FOV: 45 degrees:
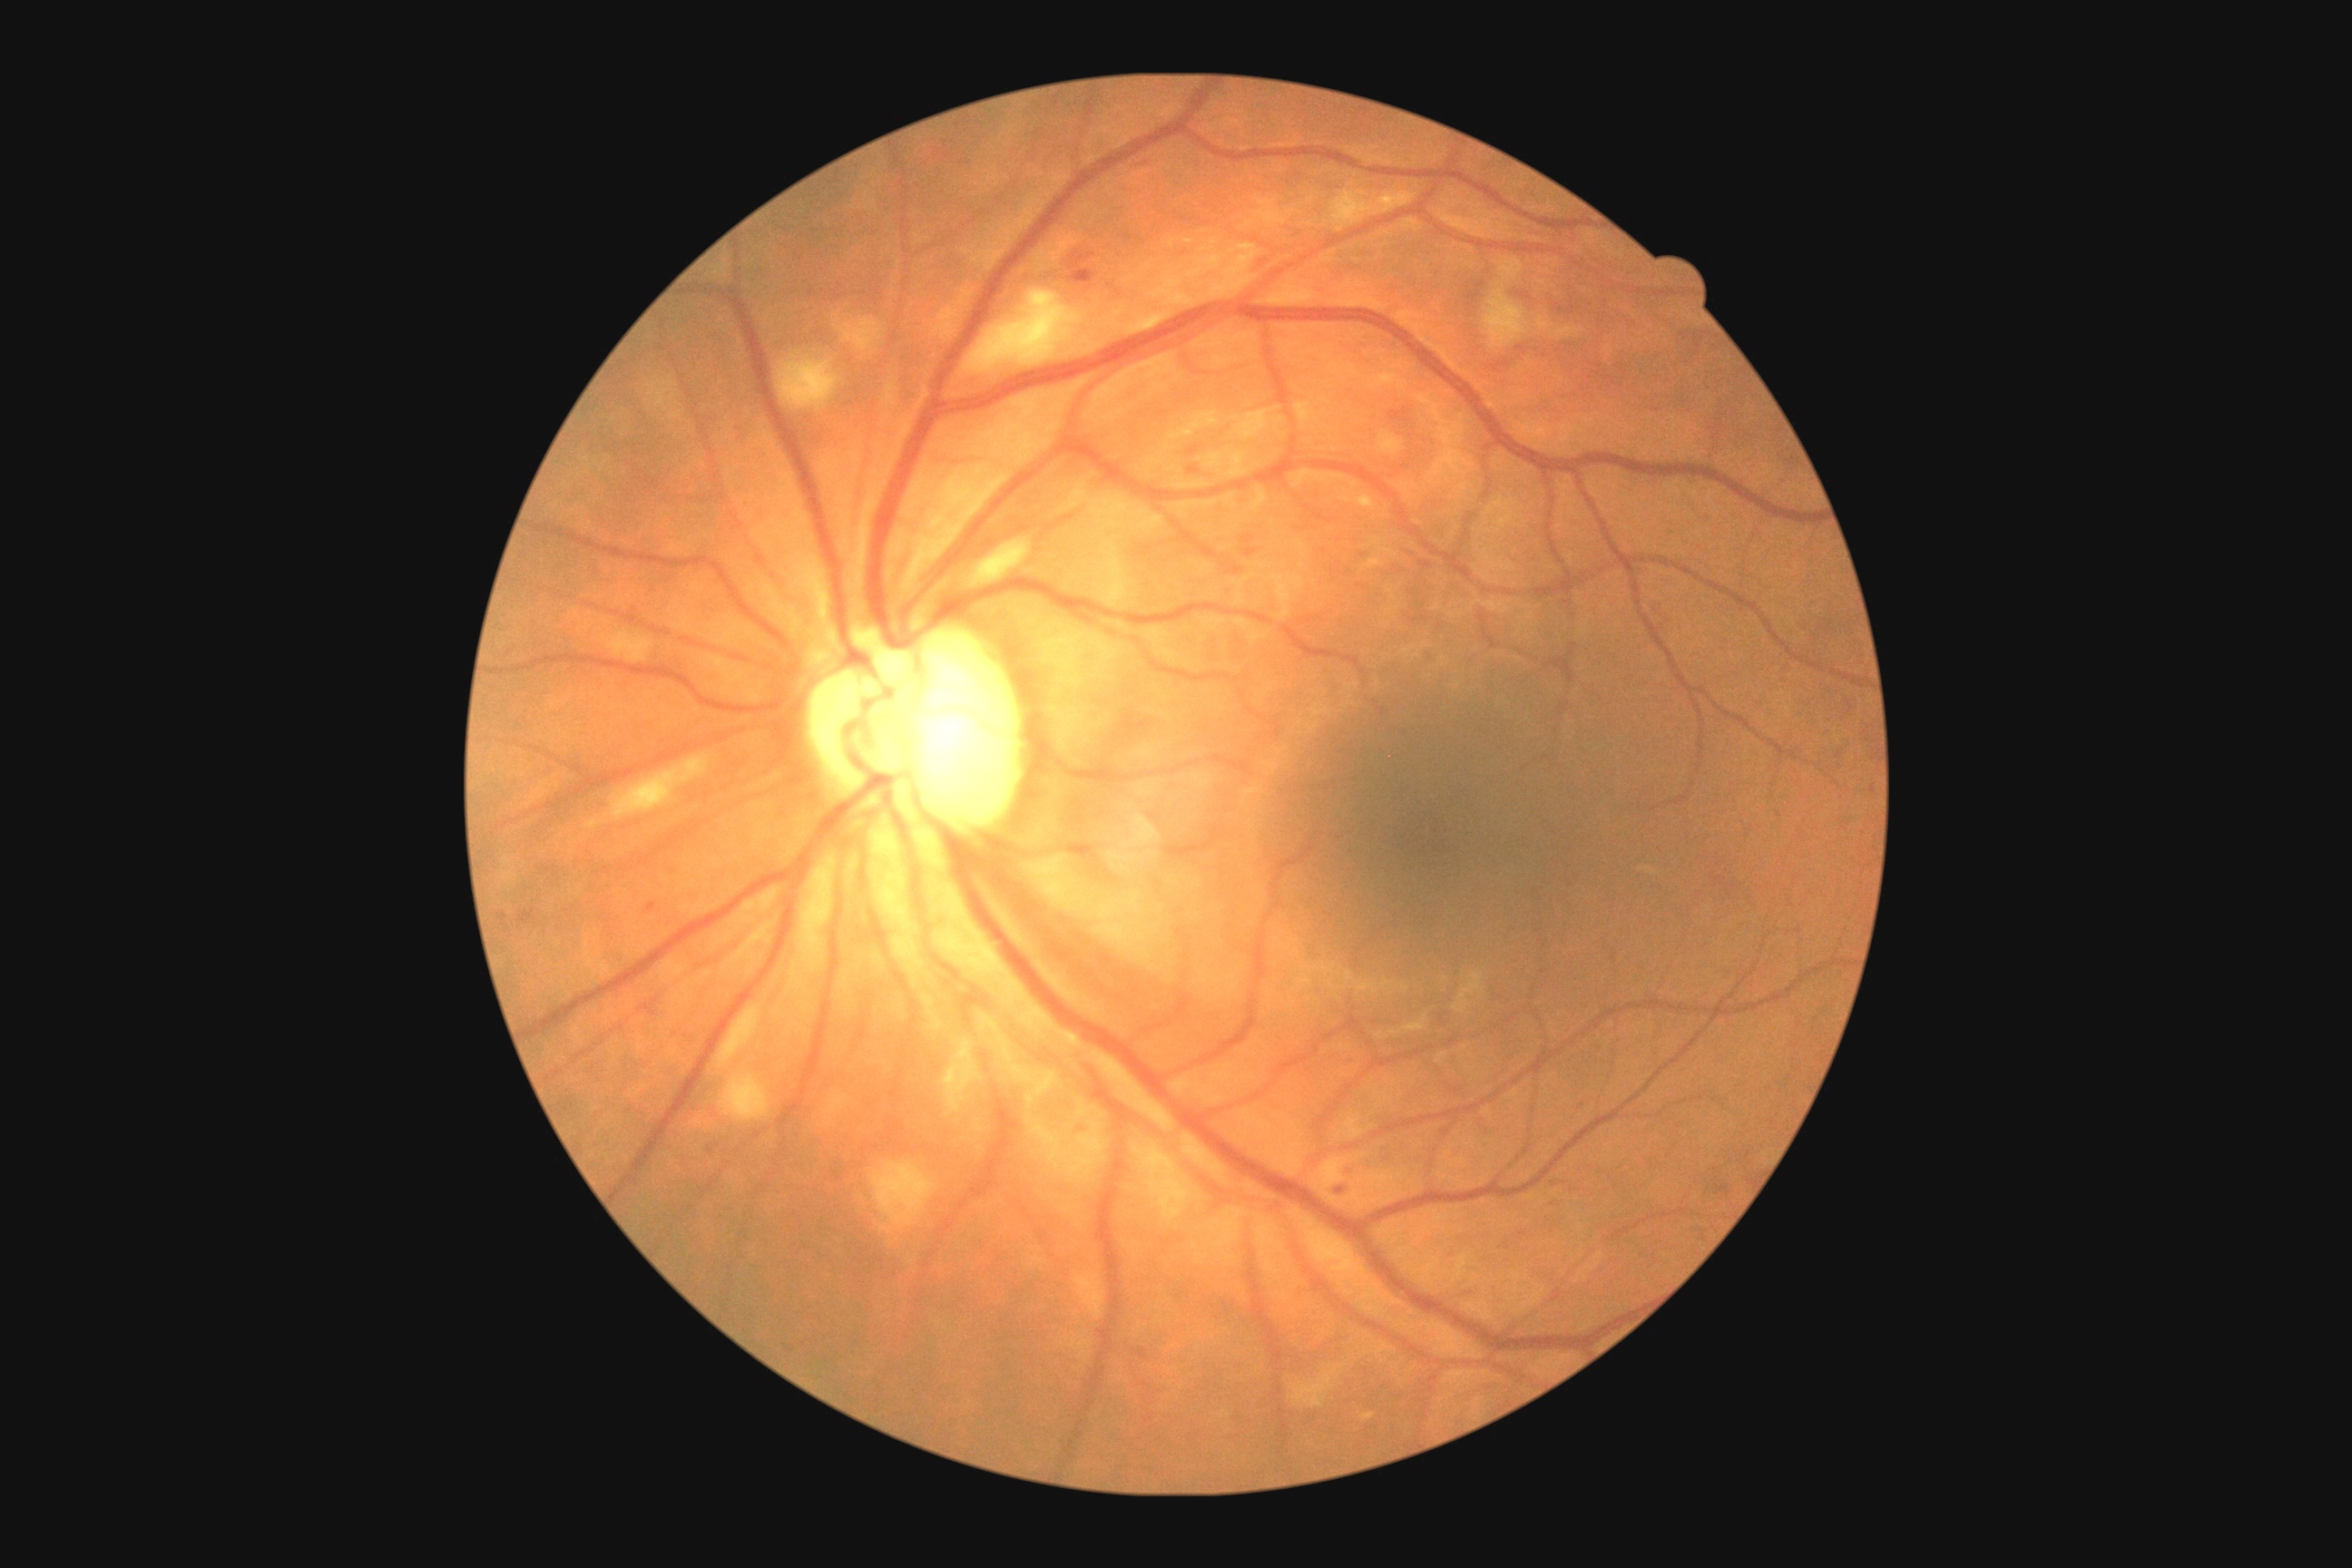
The retinopathy is classified as non-proliferative diabetic retinopathy. DR grade is 2/4.